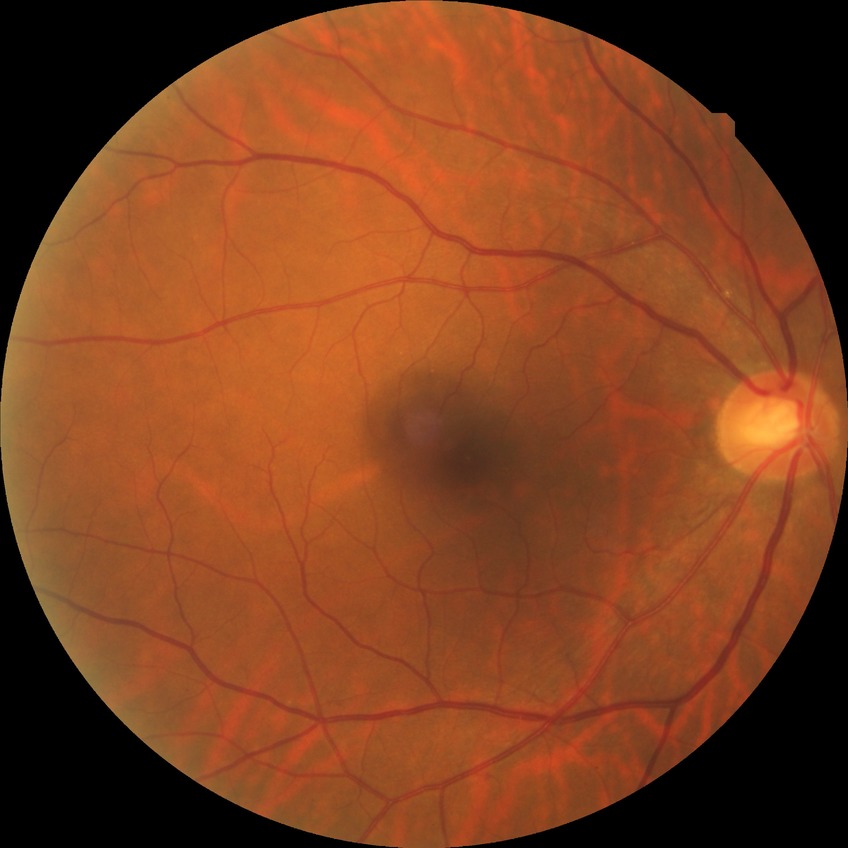   davis_grade: no diabetic retinopathy